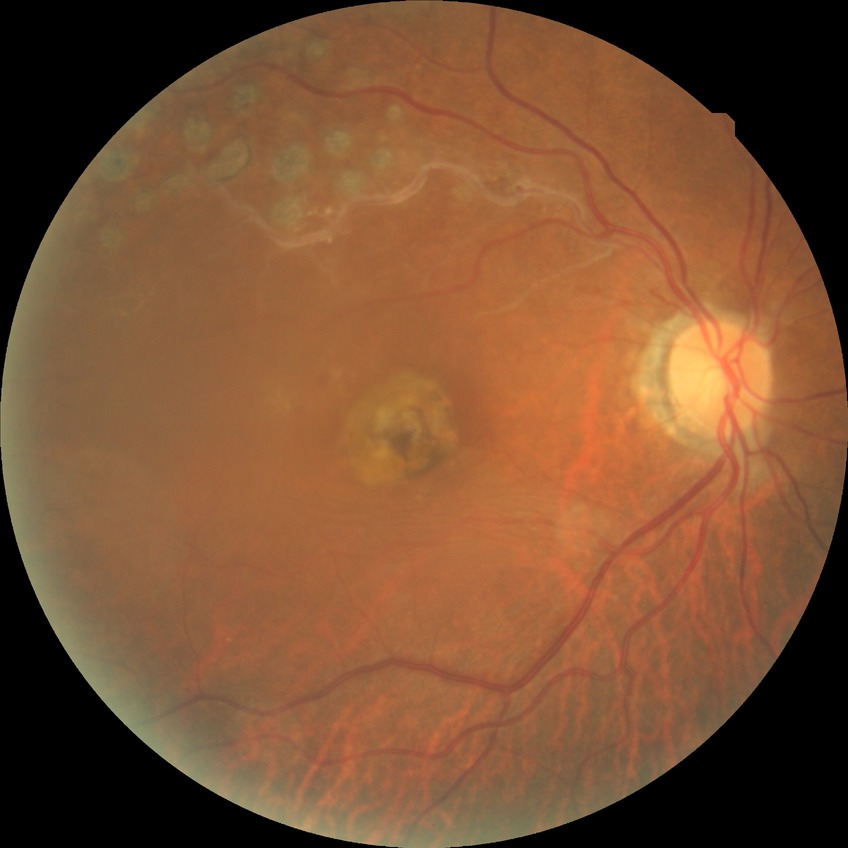

DR severity is NDR.